FOV: 45 degrees: 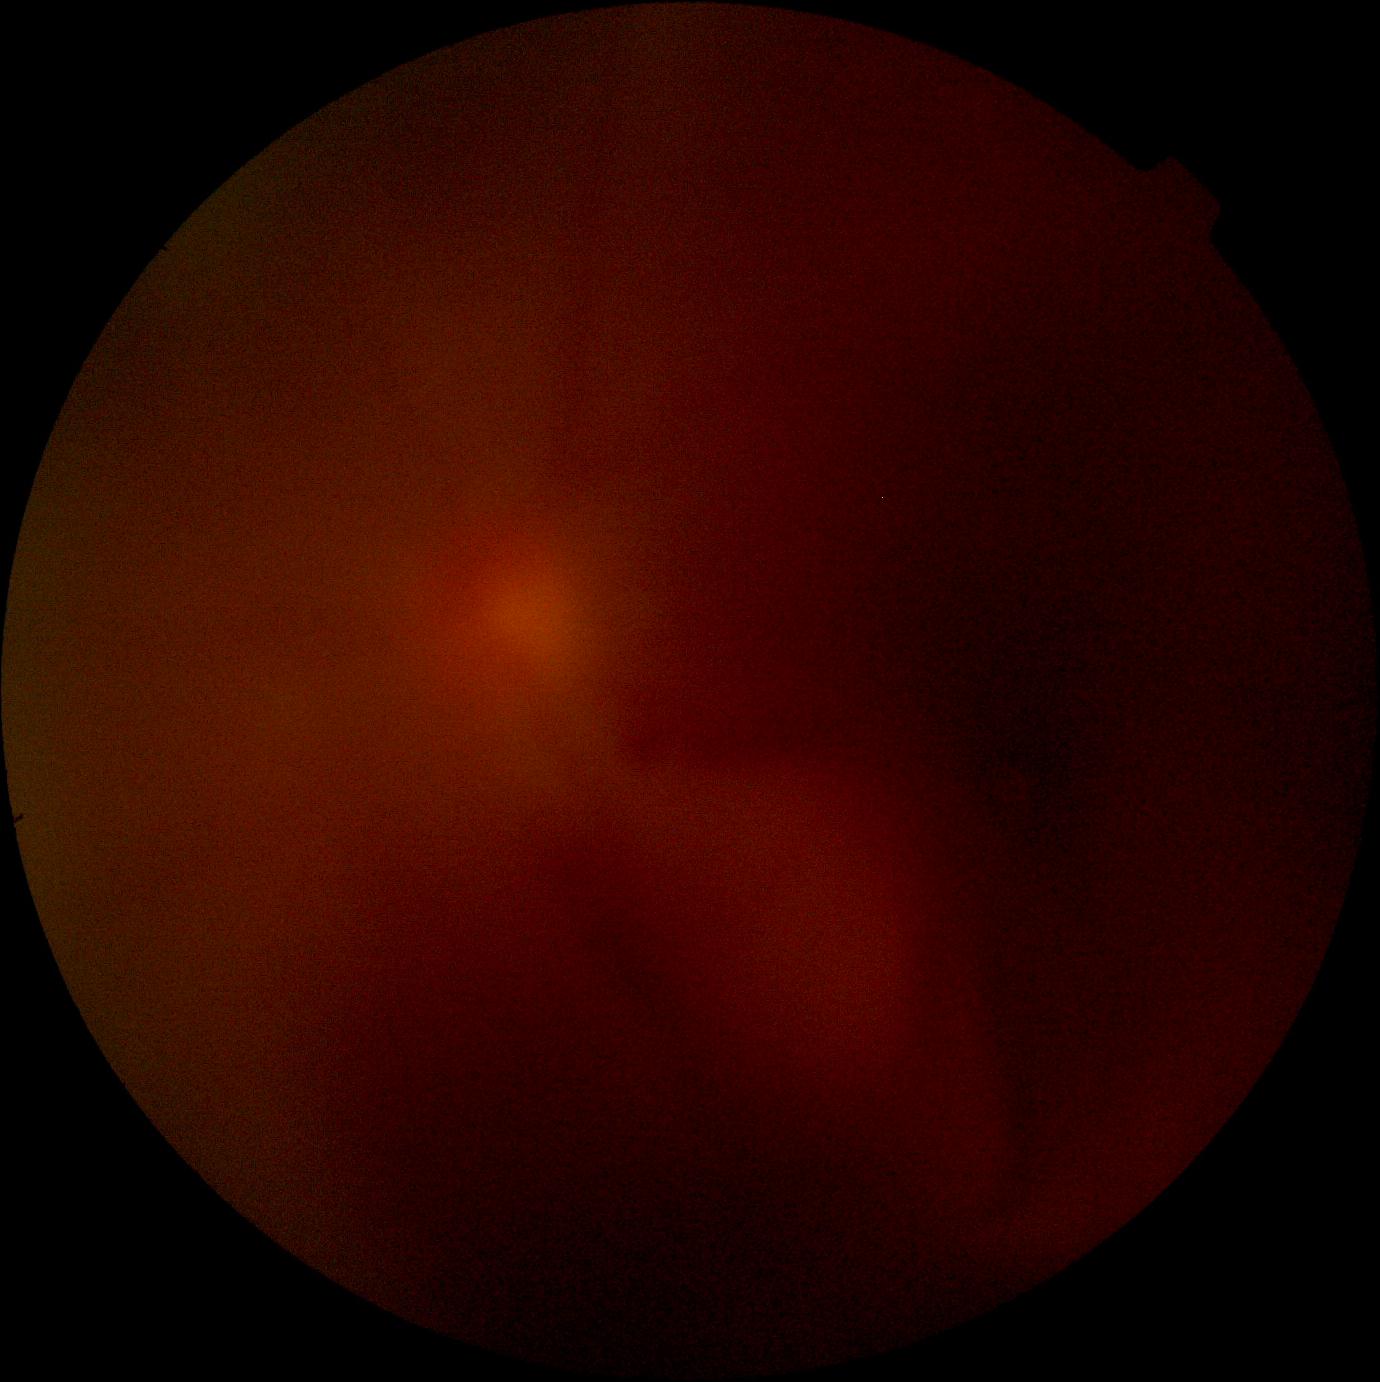
Retinopathy grade: ungradable.
The image cannot be graded for diabetic retinopathy.